45° field of view — 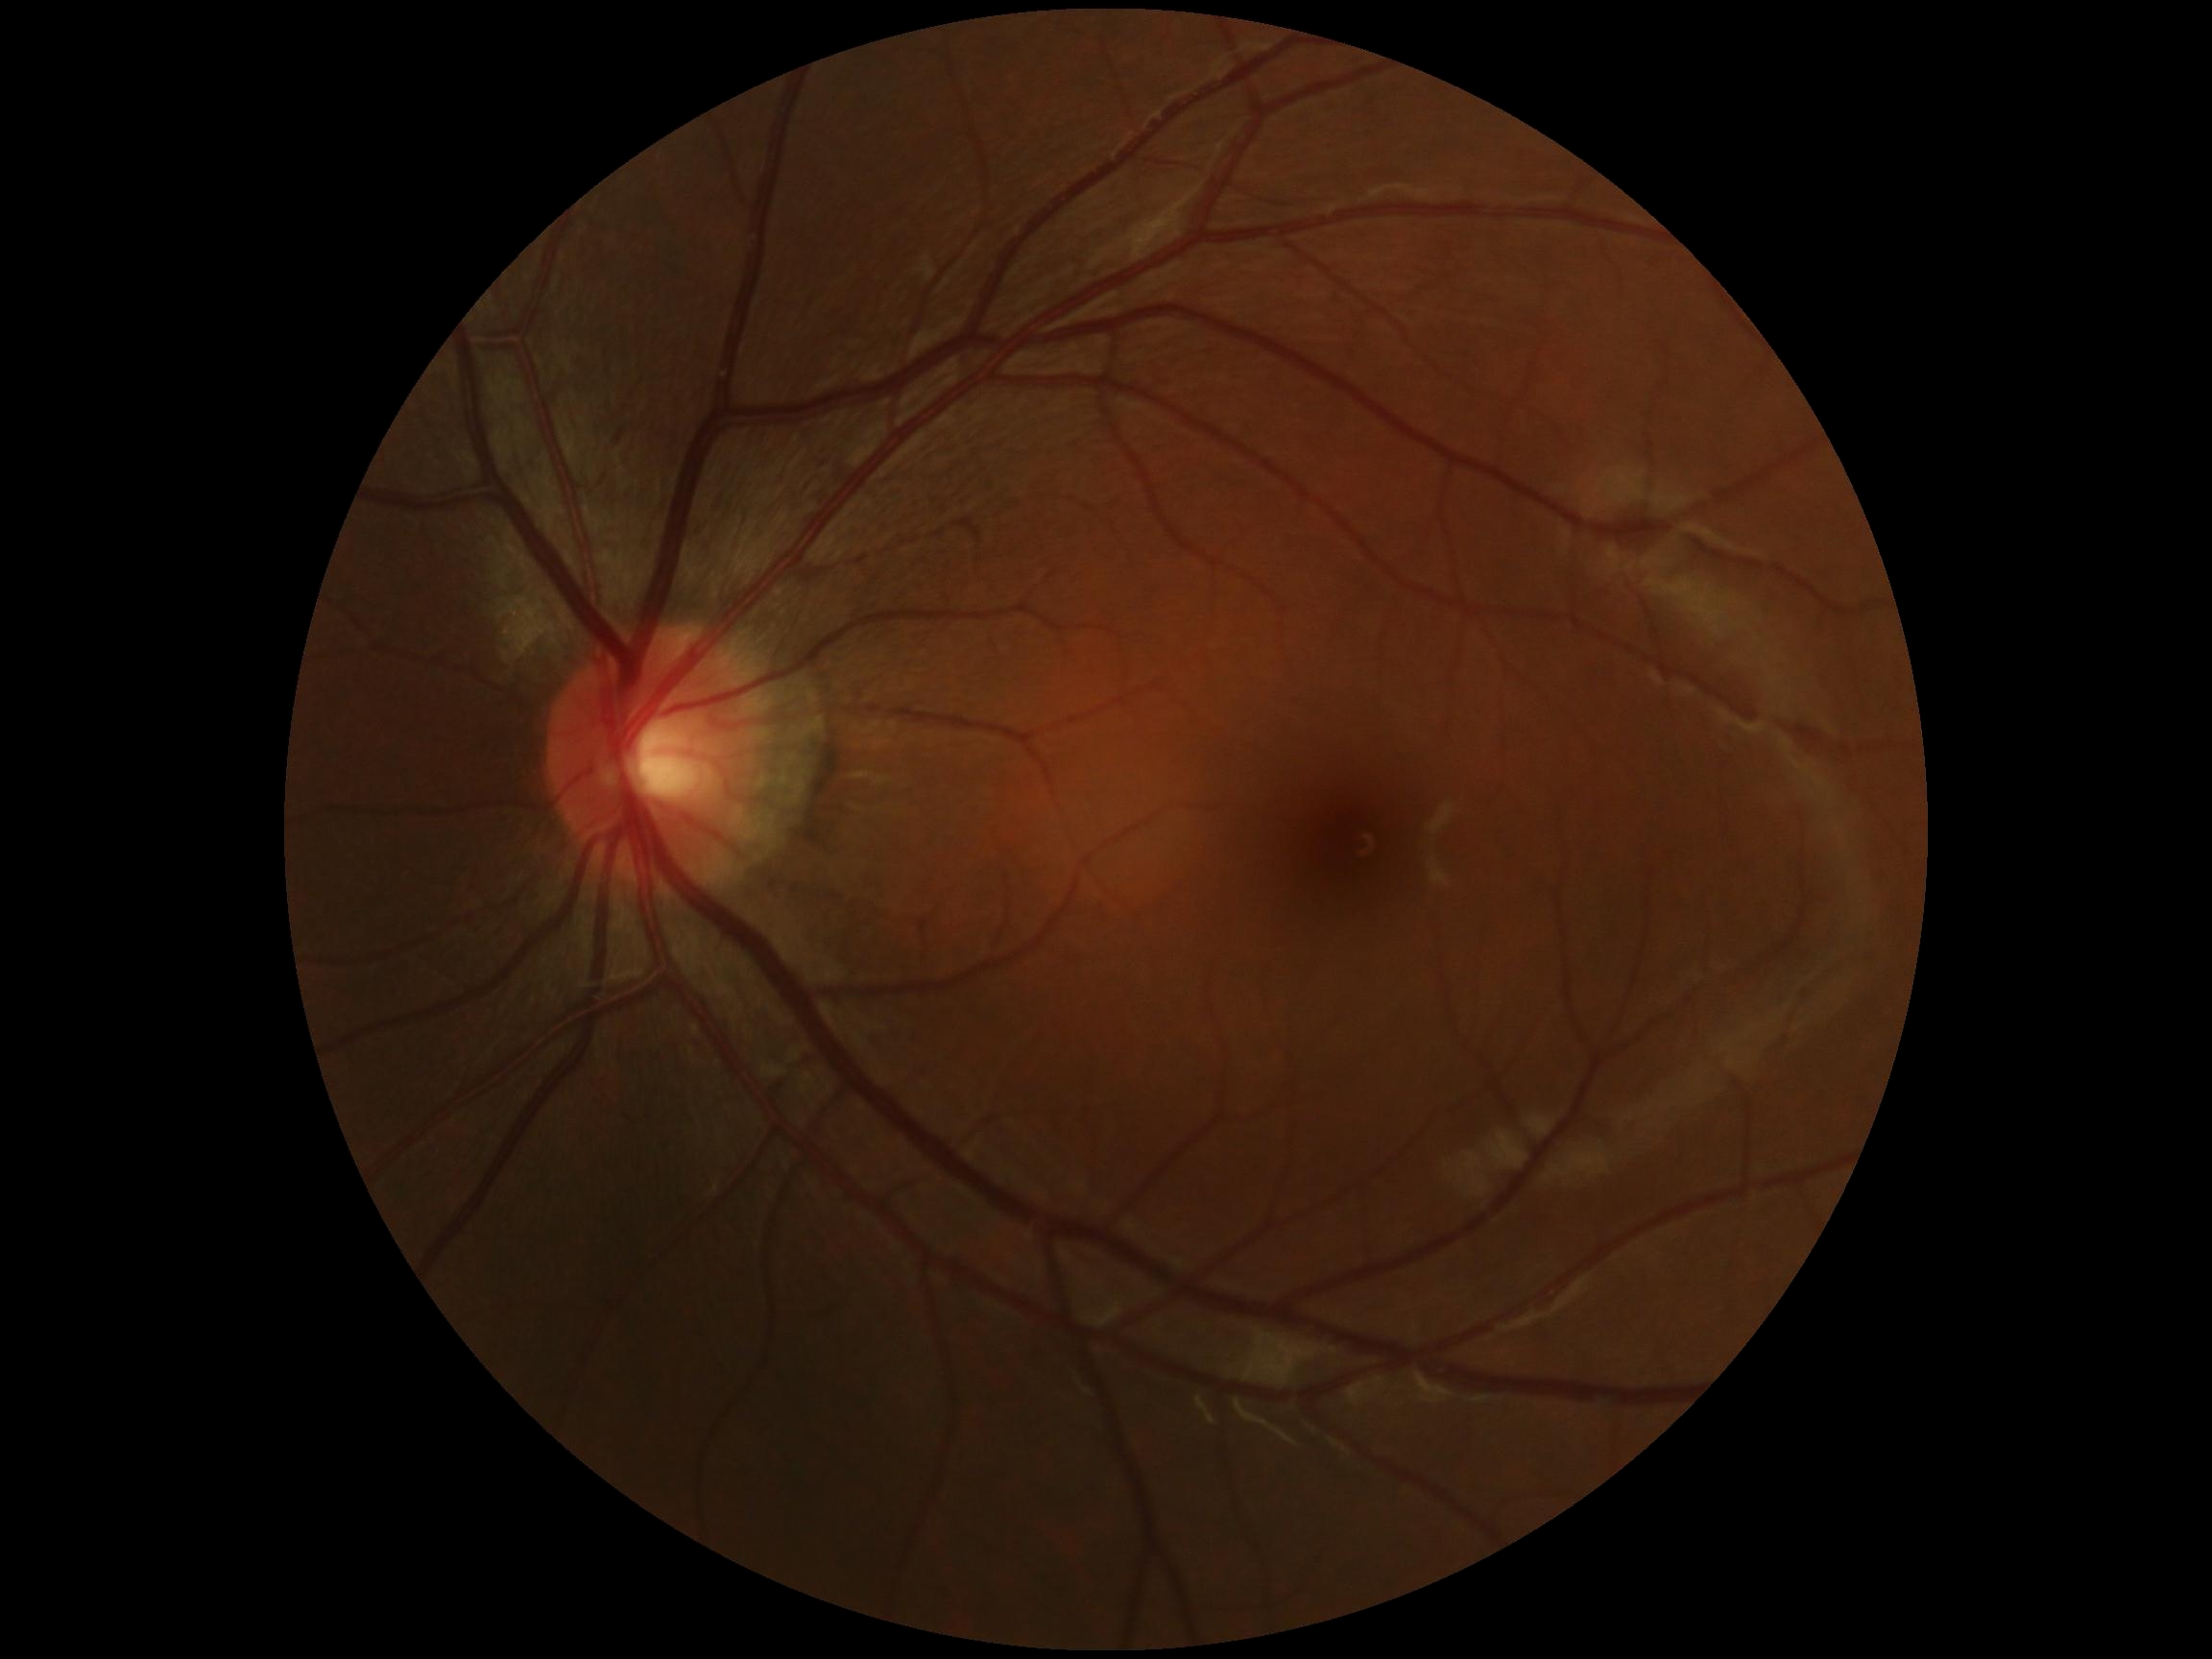 DR grade is 0.